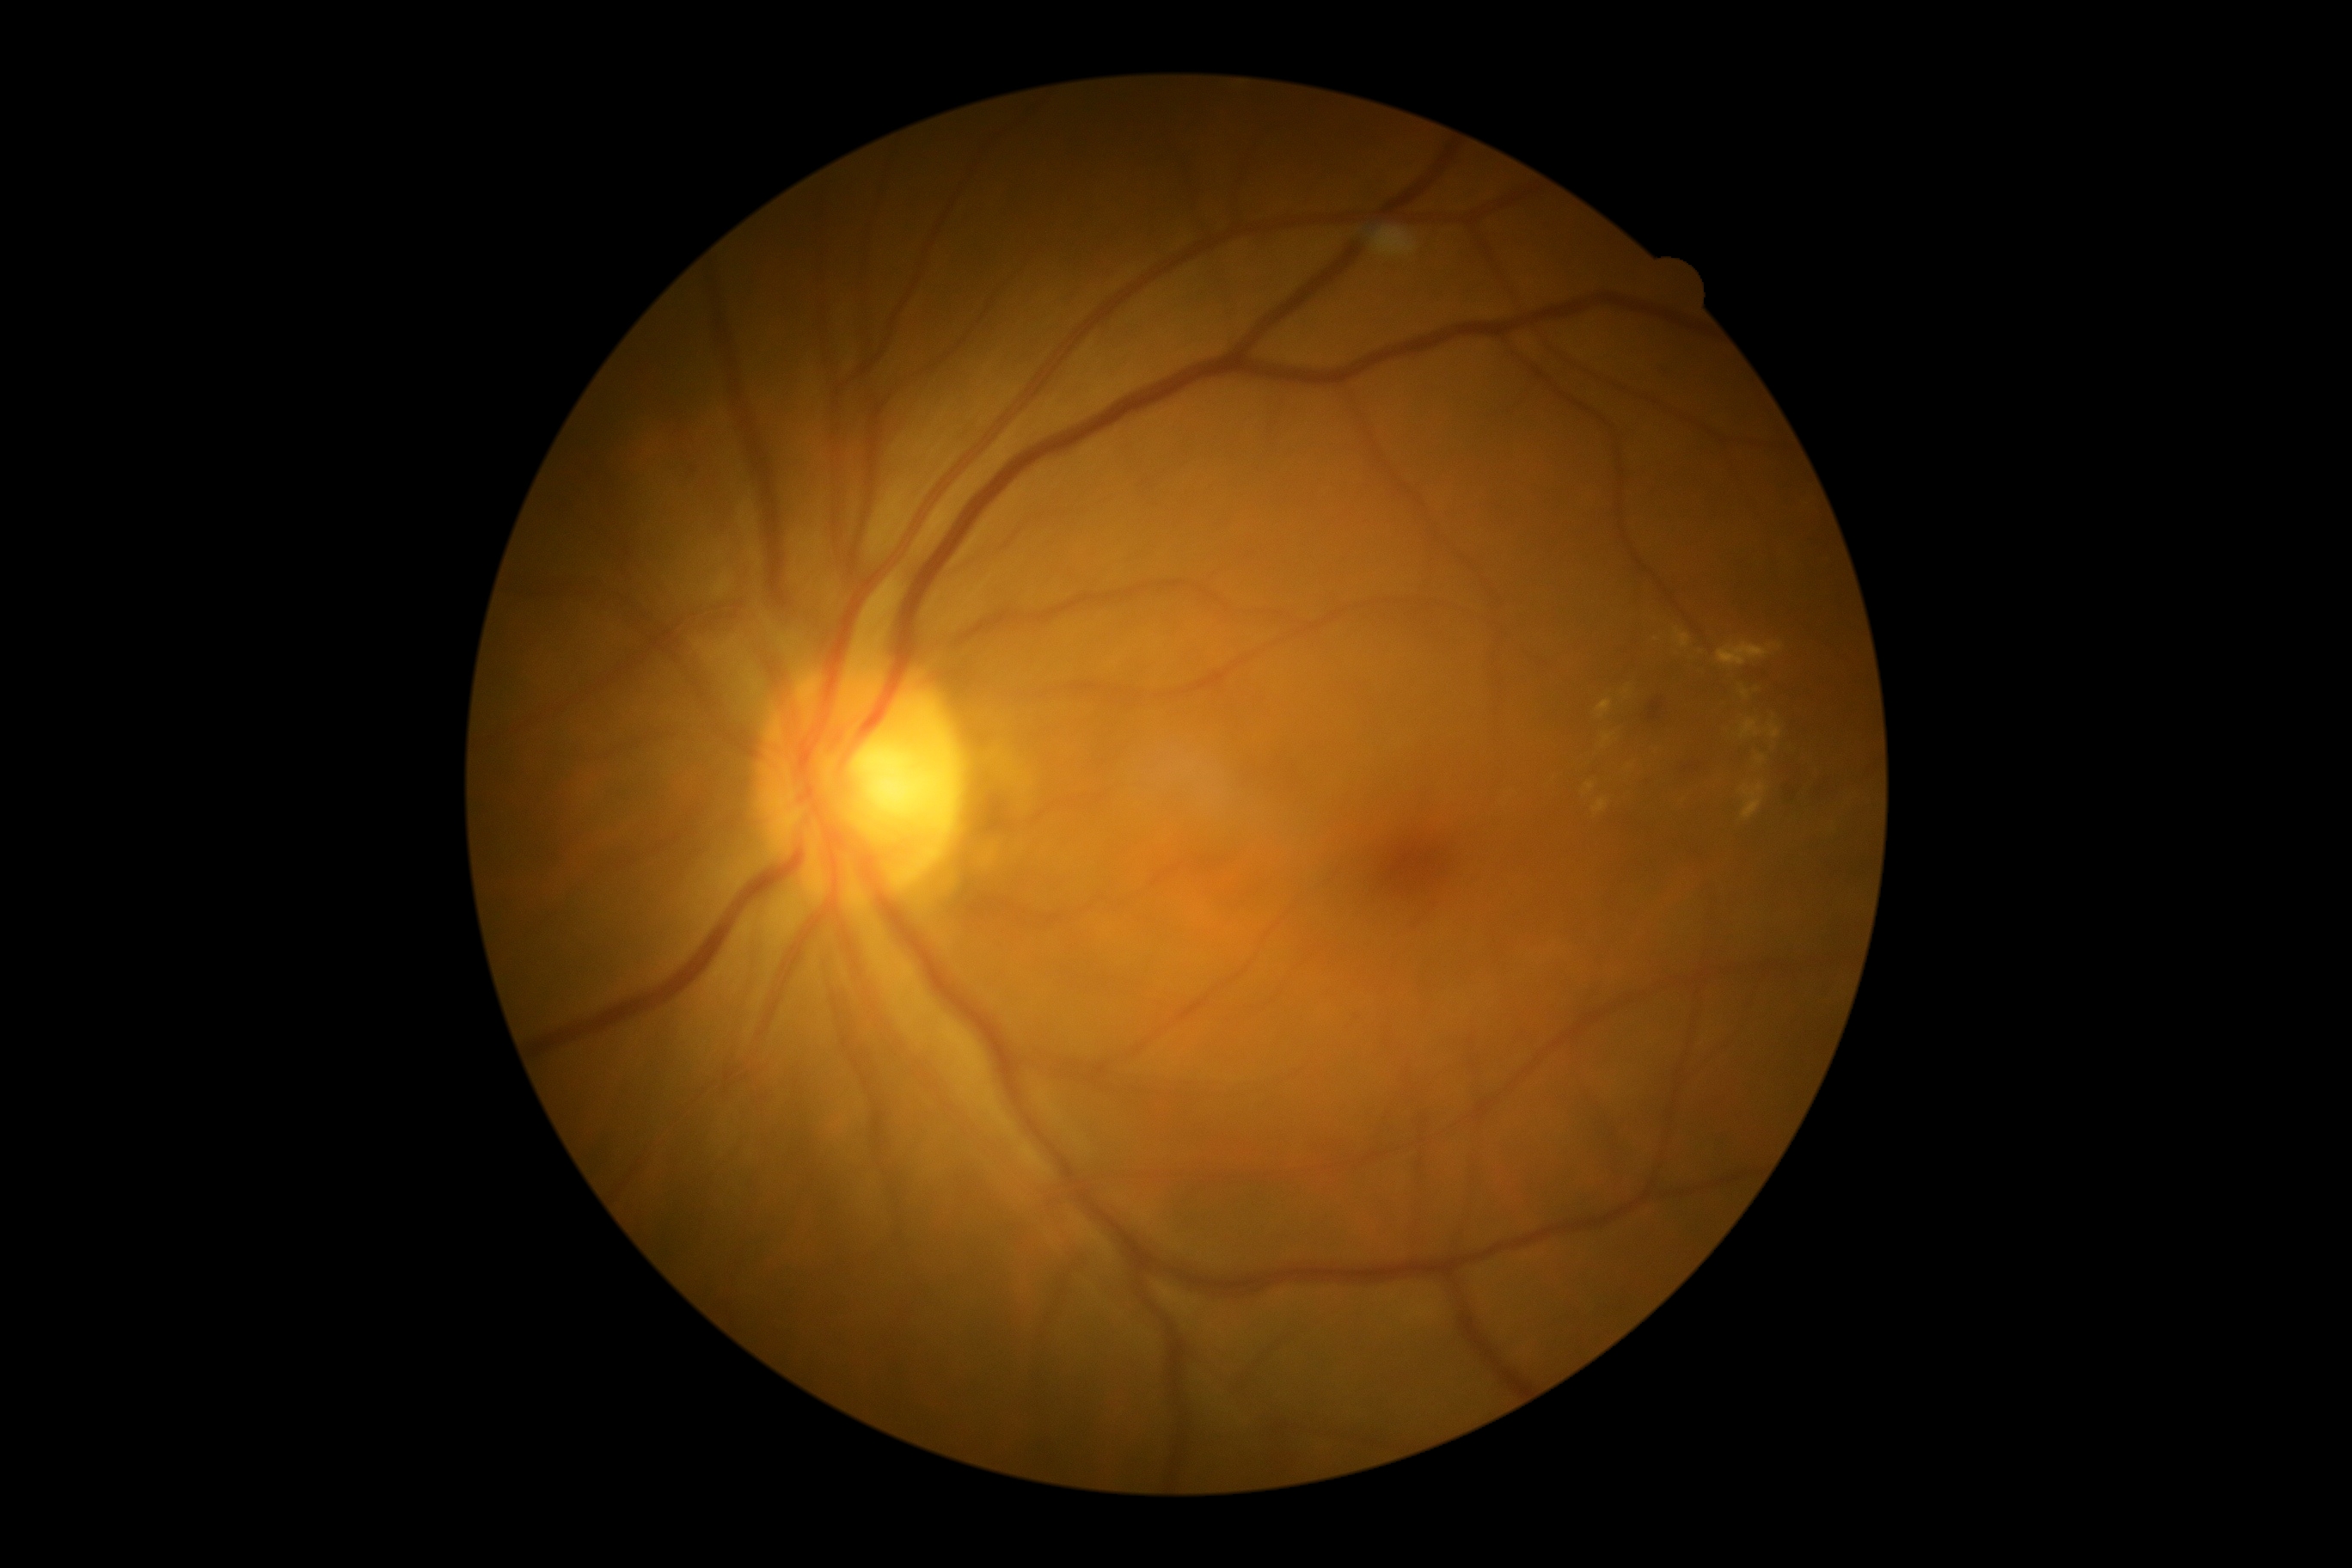

diabetic retinopathy = 2/4 | DR class = non-proliferative diabetic retinopathy.